Clarity RetCam 3, 130° FOV; 640x480; pediatric wide-field fundus photograph.
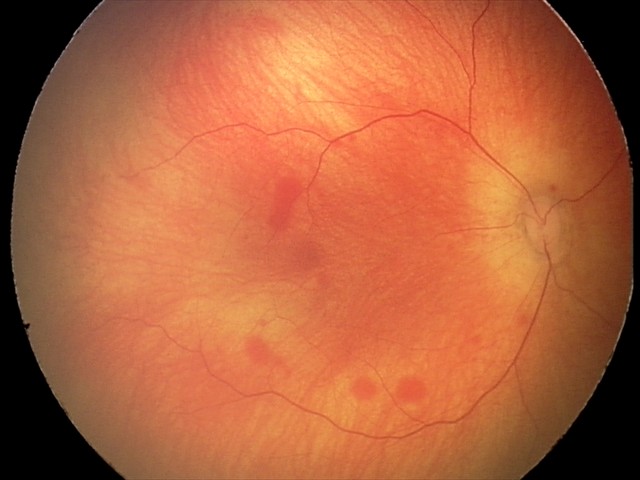
Screening series with retinal hemorrhages.